DR severity per modified Davis staging
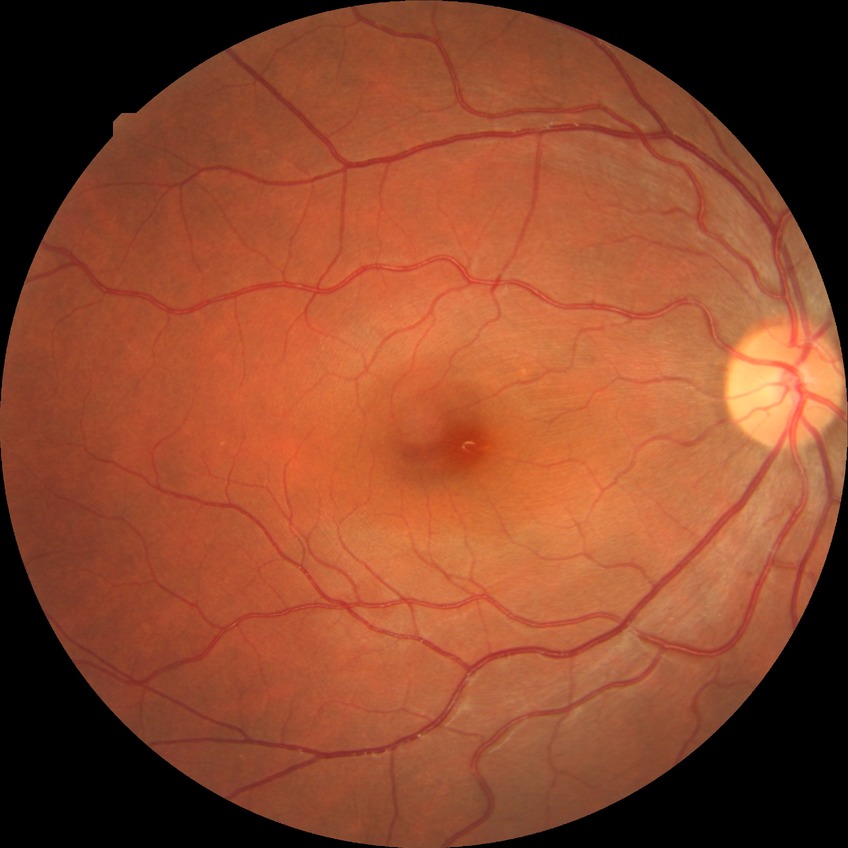
Modified Davis grading is no diabetic retinopathy.